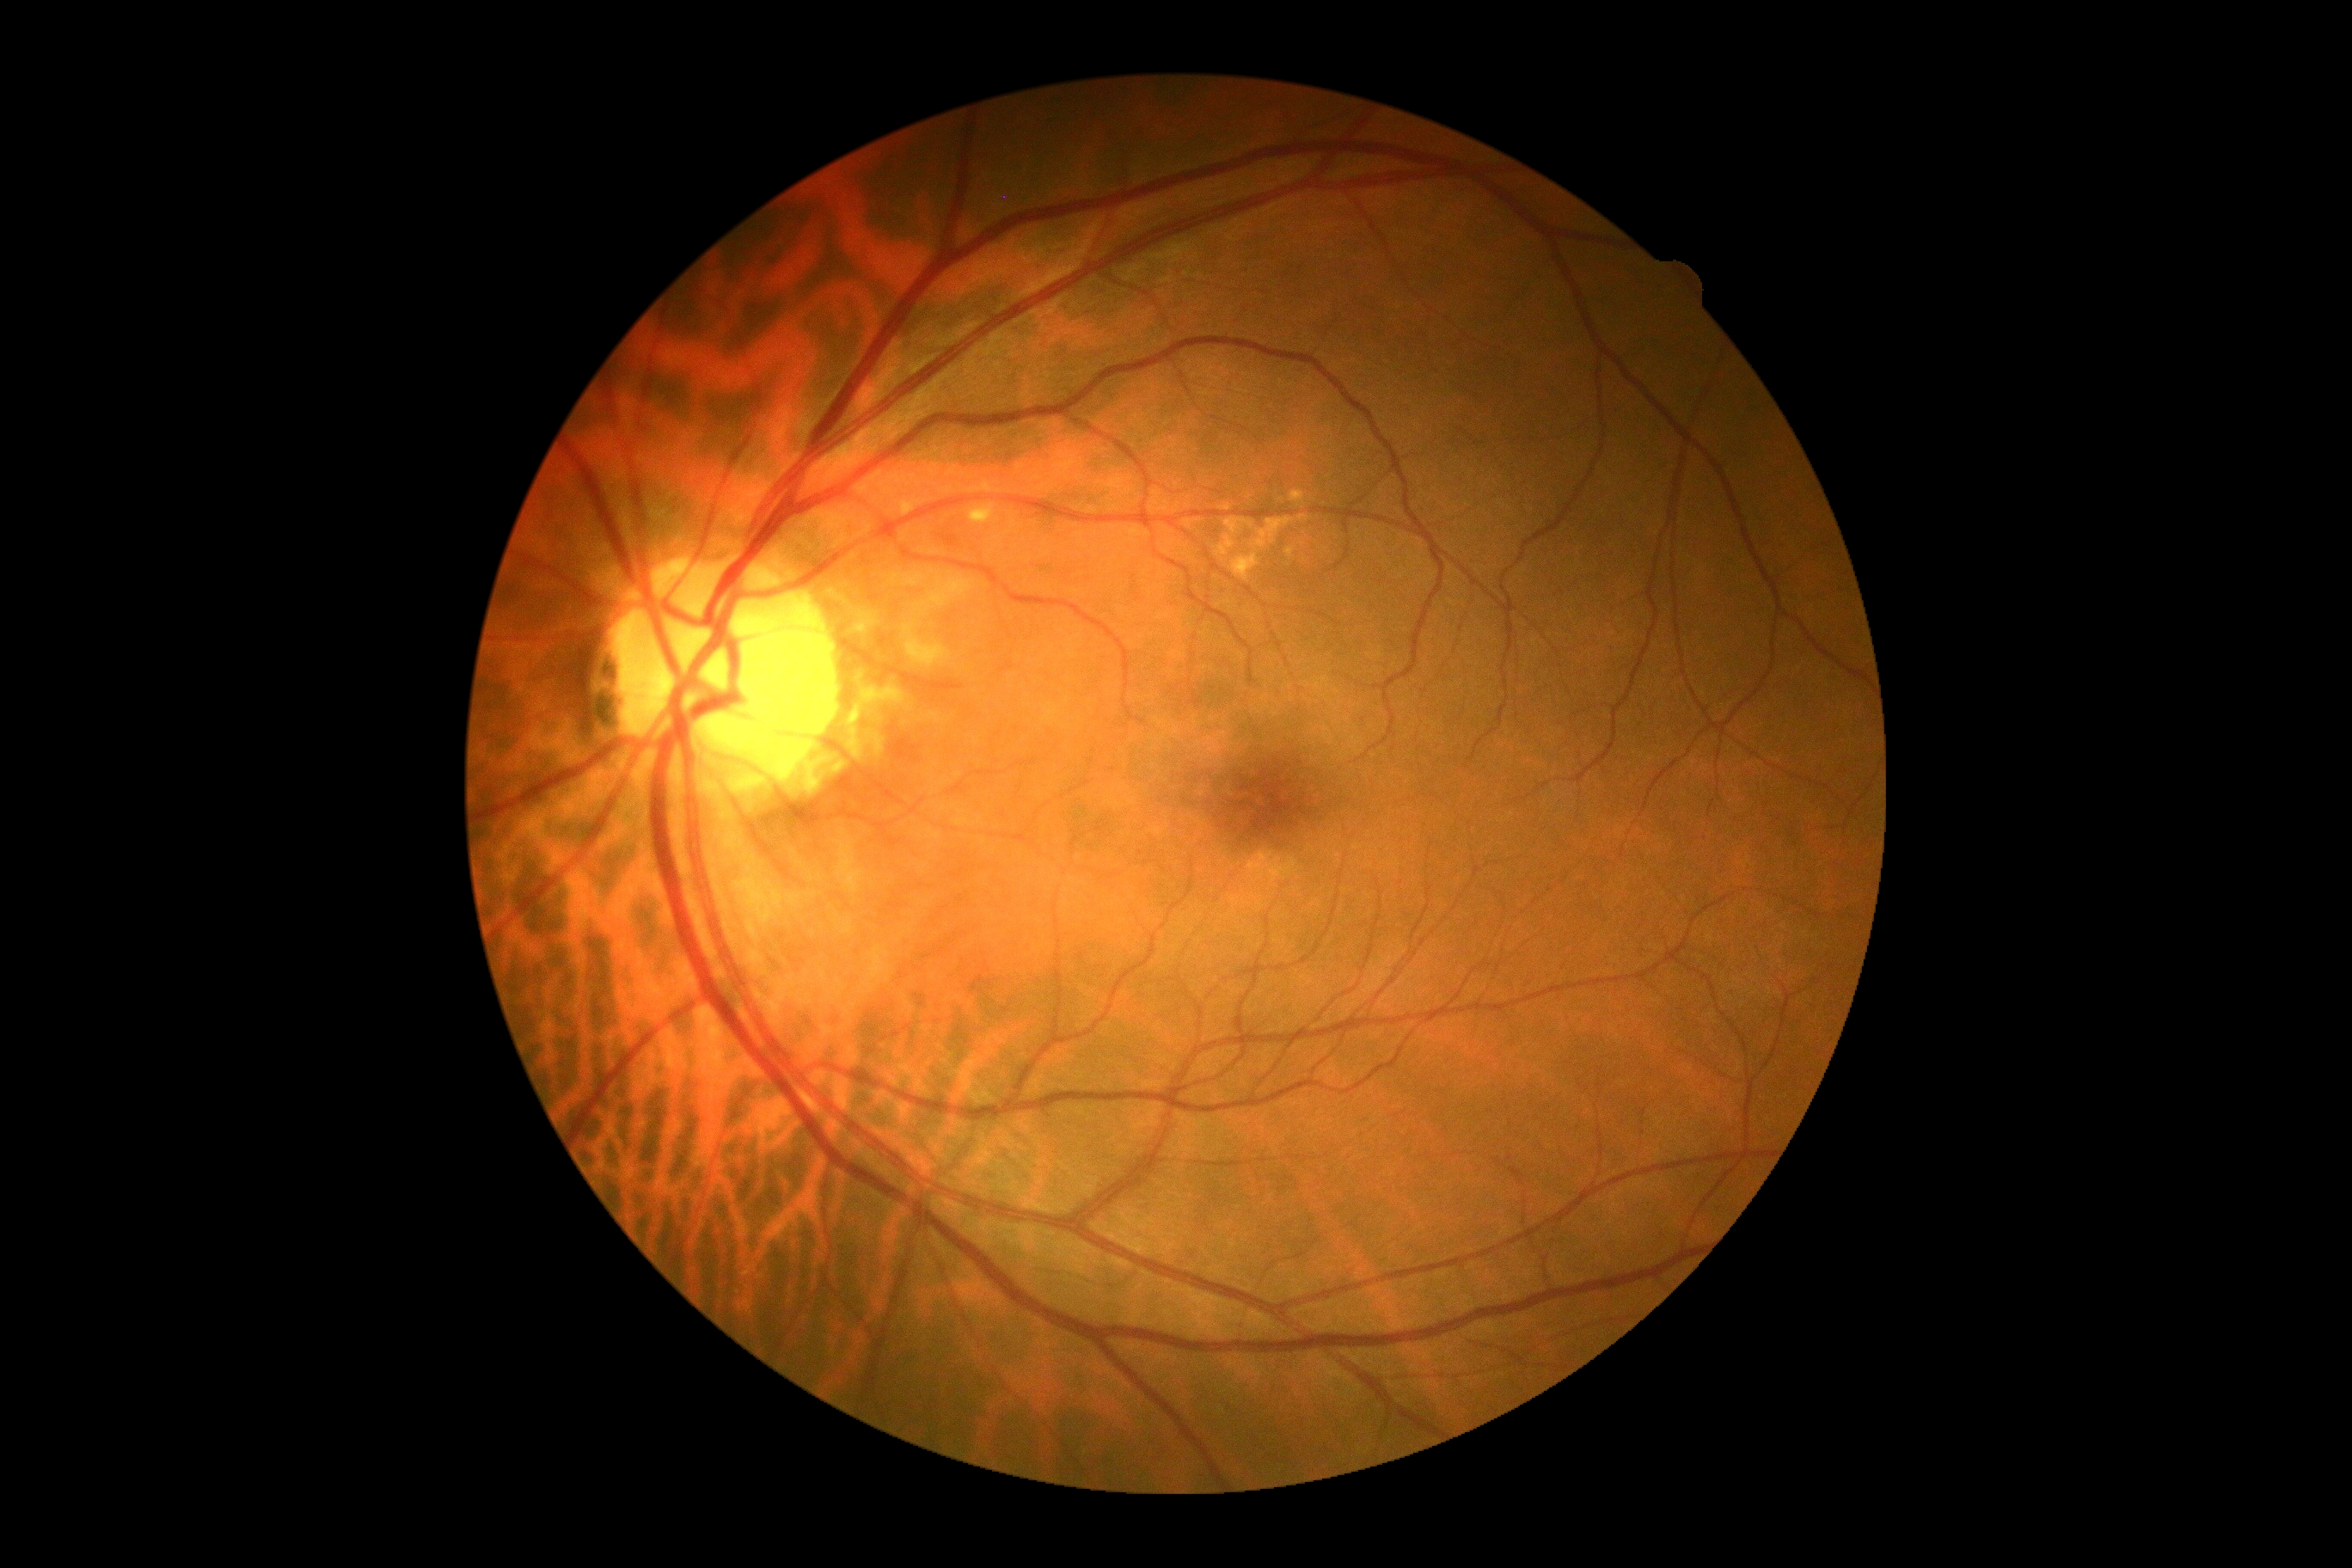 Retinopathy: 0/4.